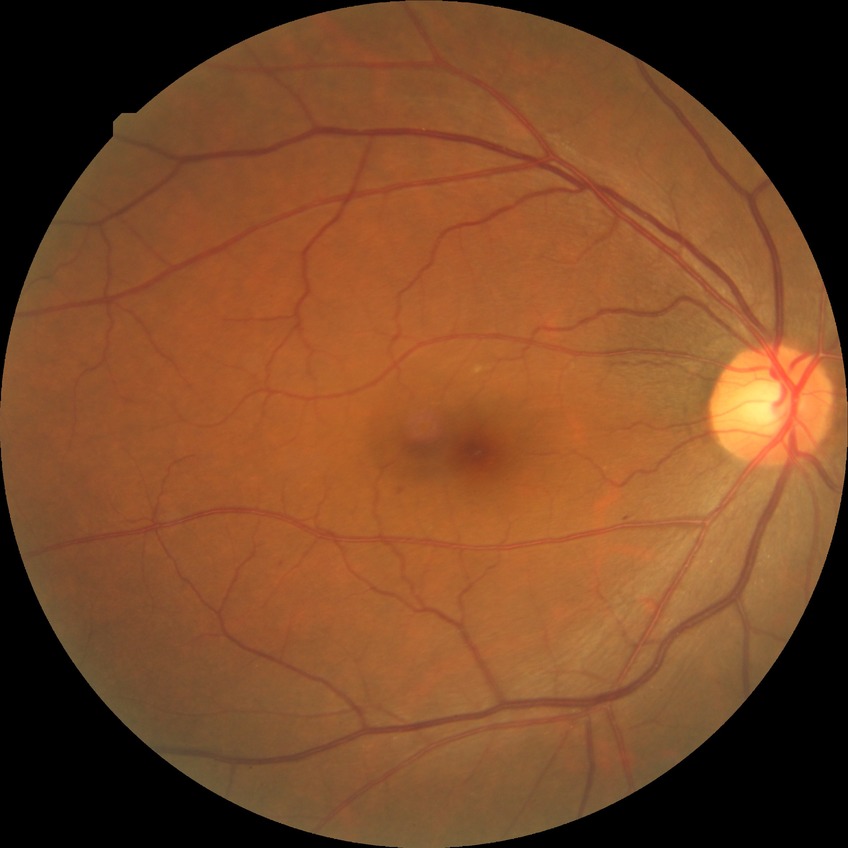

diabetic retinopathy grade=simple diabetic retinopathy; DR class=non-proliferative diabetic retinopathy.